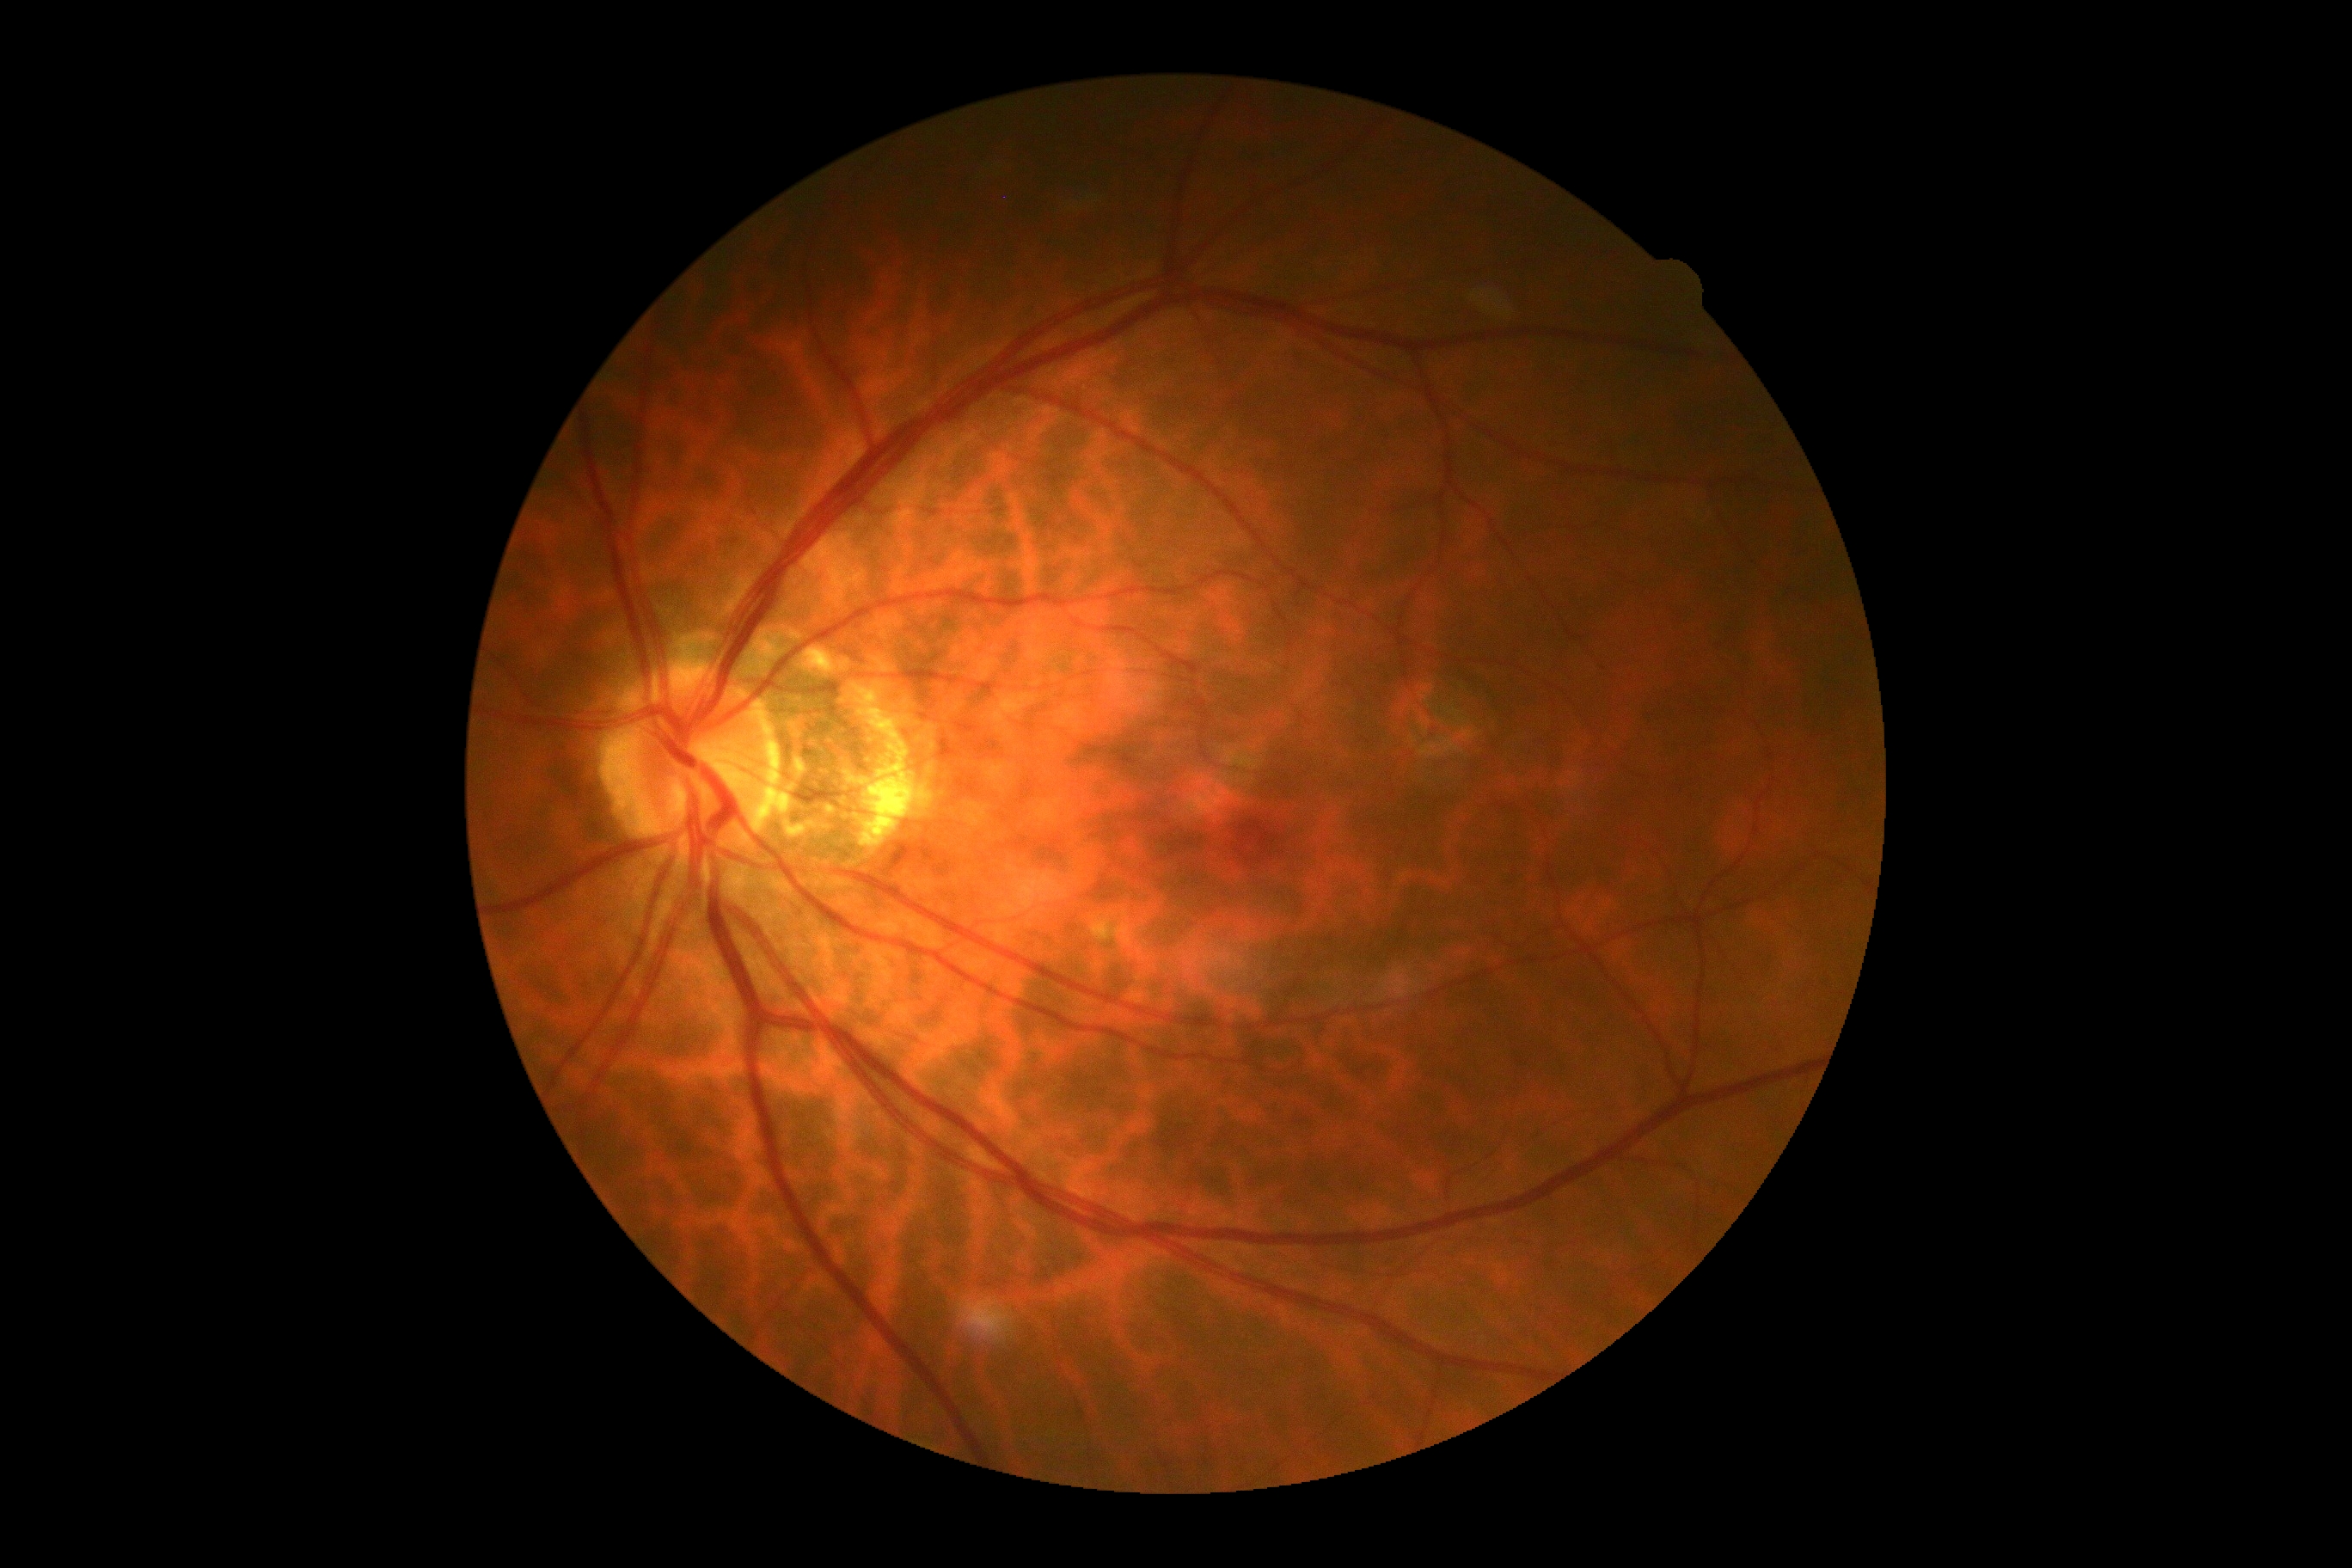 DR grade is no apparent retinopathy (0). No diabetic retinal disease findings.